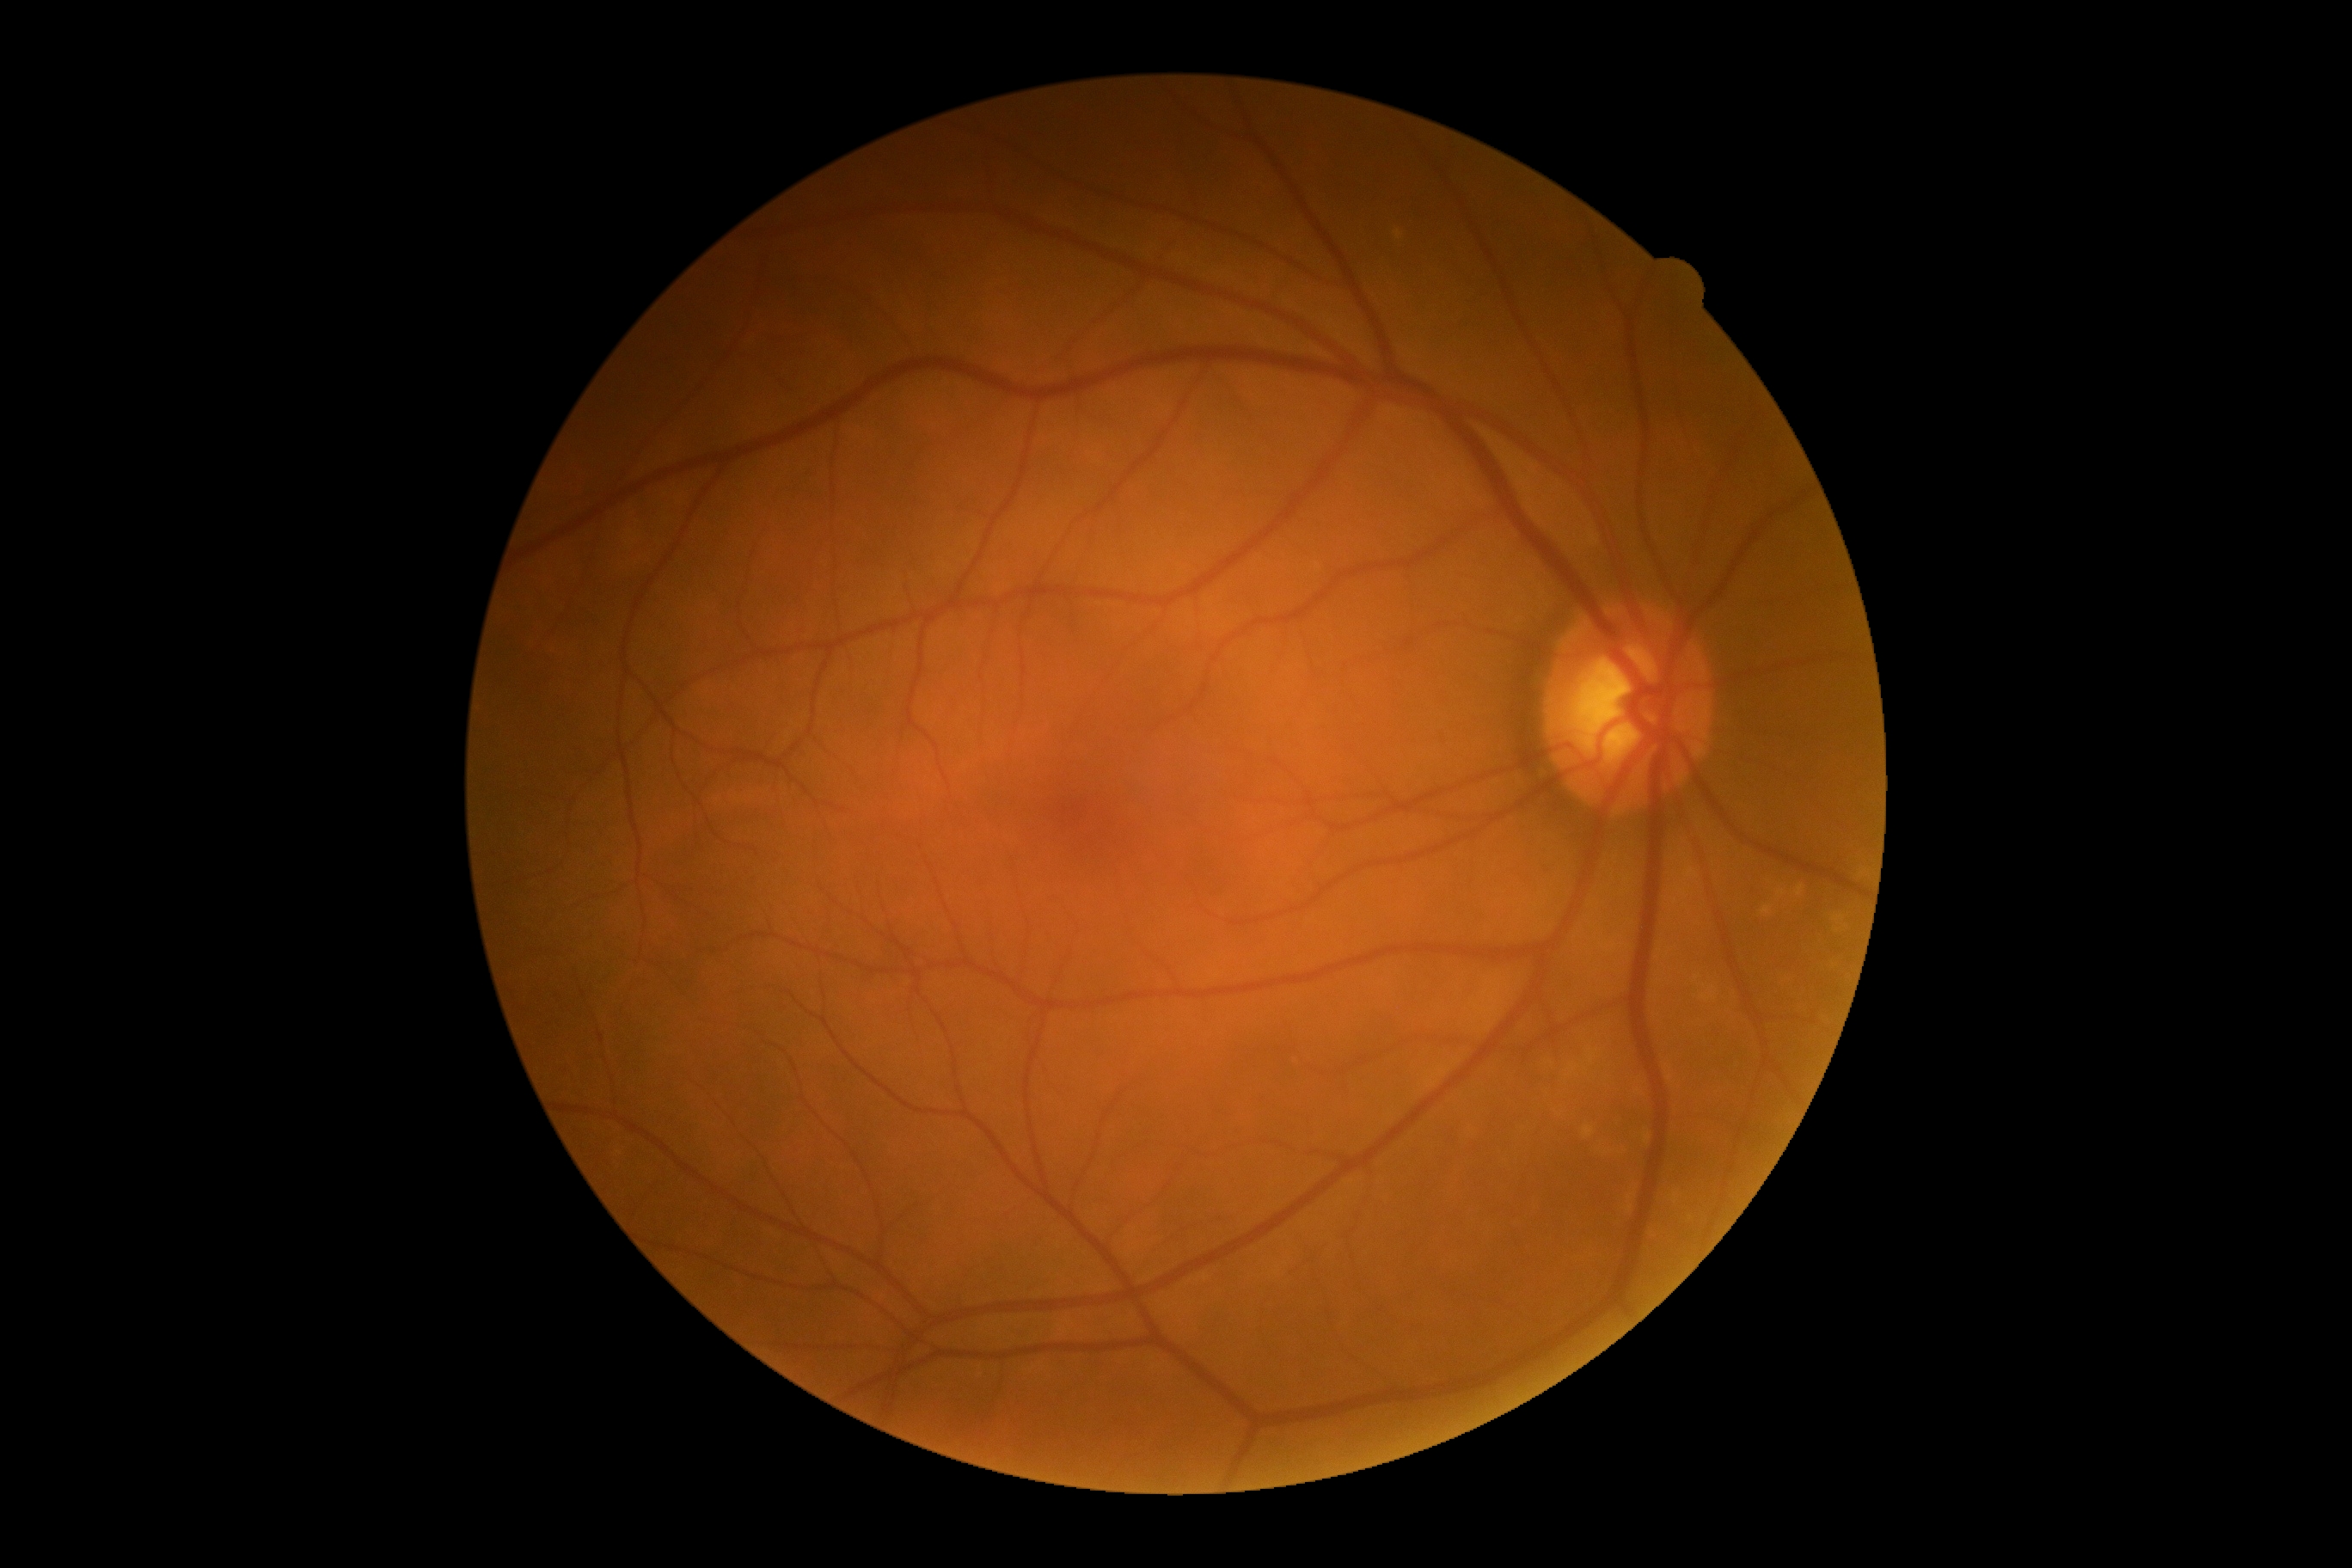
DR is no apparent retinopathy (grade 0).
No diabetic retinal disease findings.